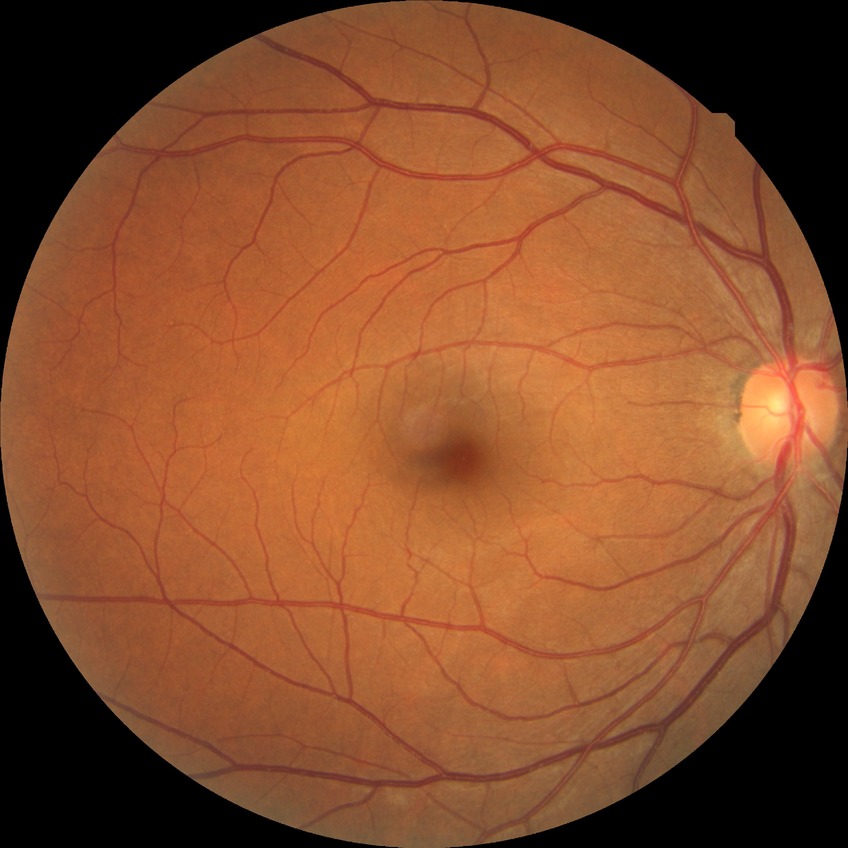 Diabetic retinopathy (DR): no diabetic retinopathy (NDR).